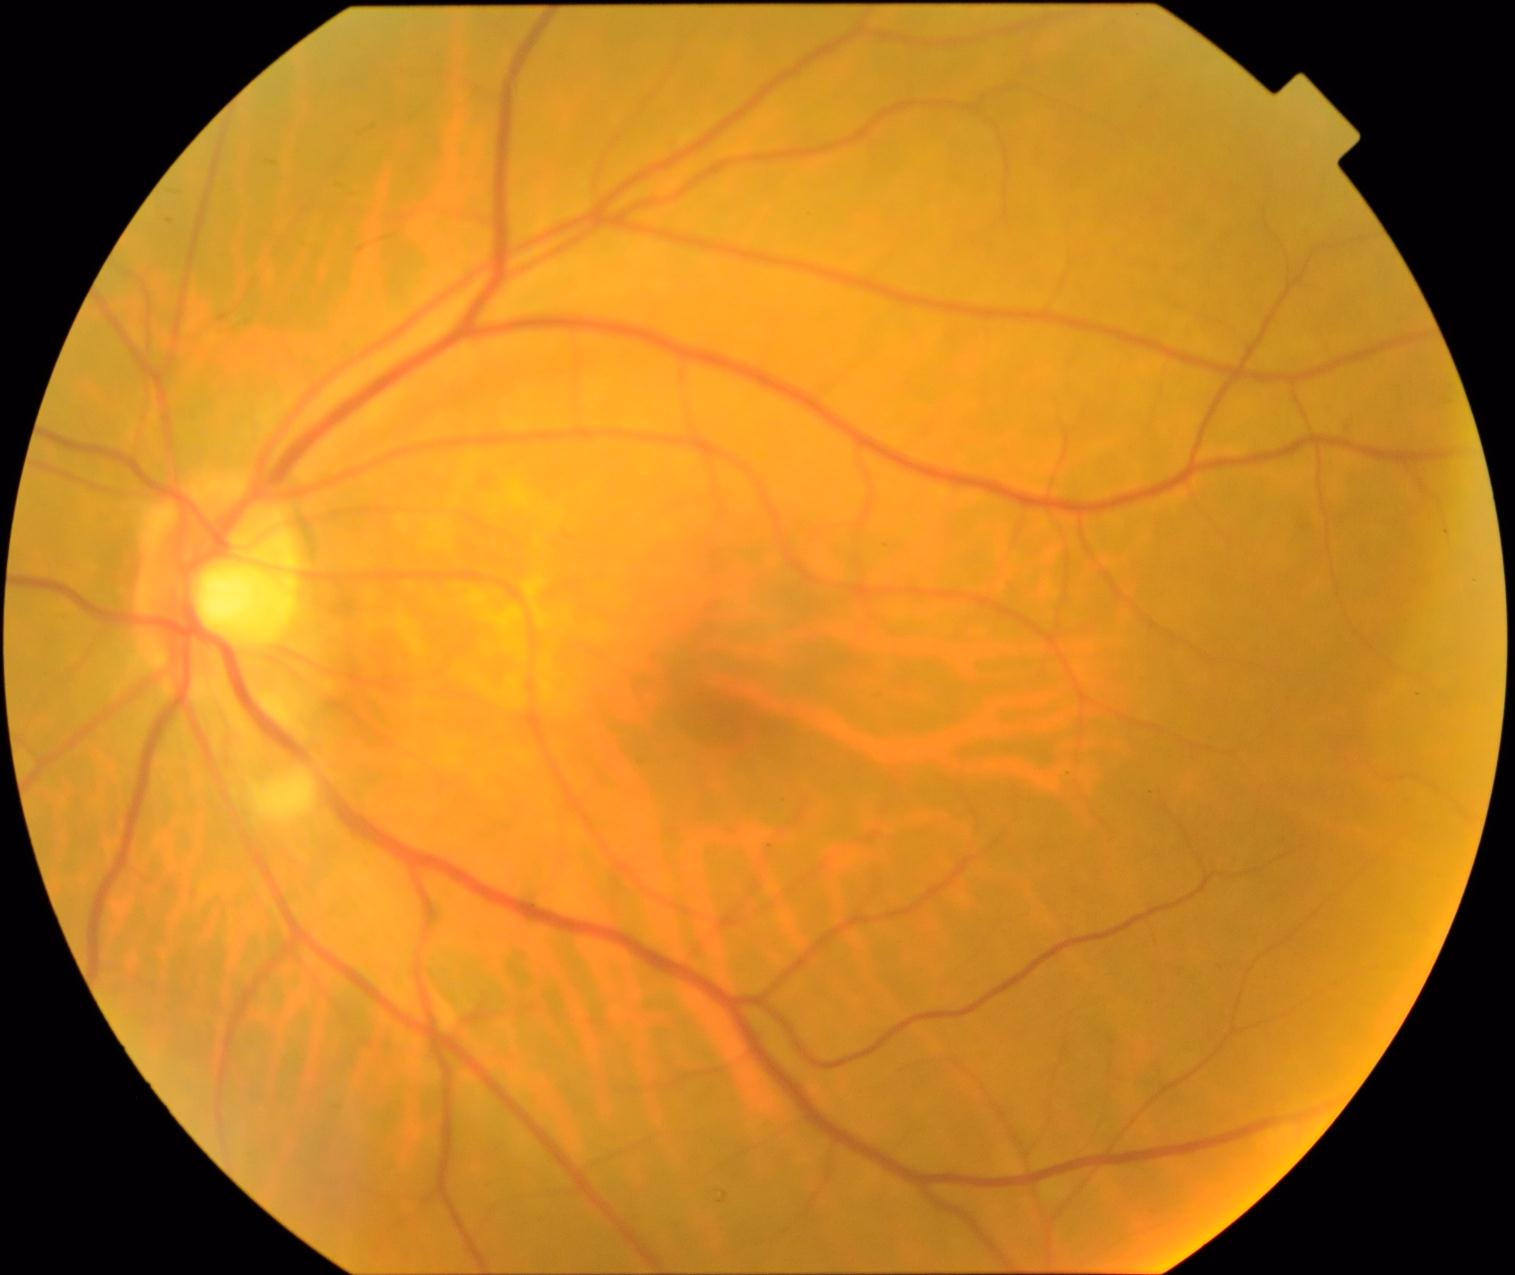 The retinopathy is classified as non-proliferative diabetic retinopathy.
Diabetic retinopathy is 2/4.